CFP, 2102x1736:
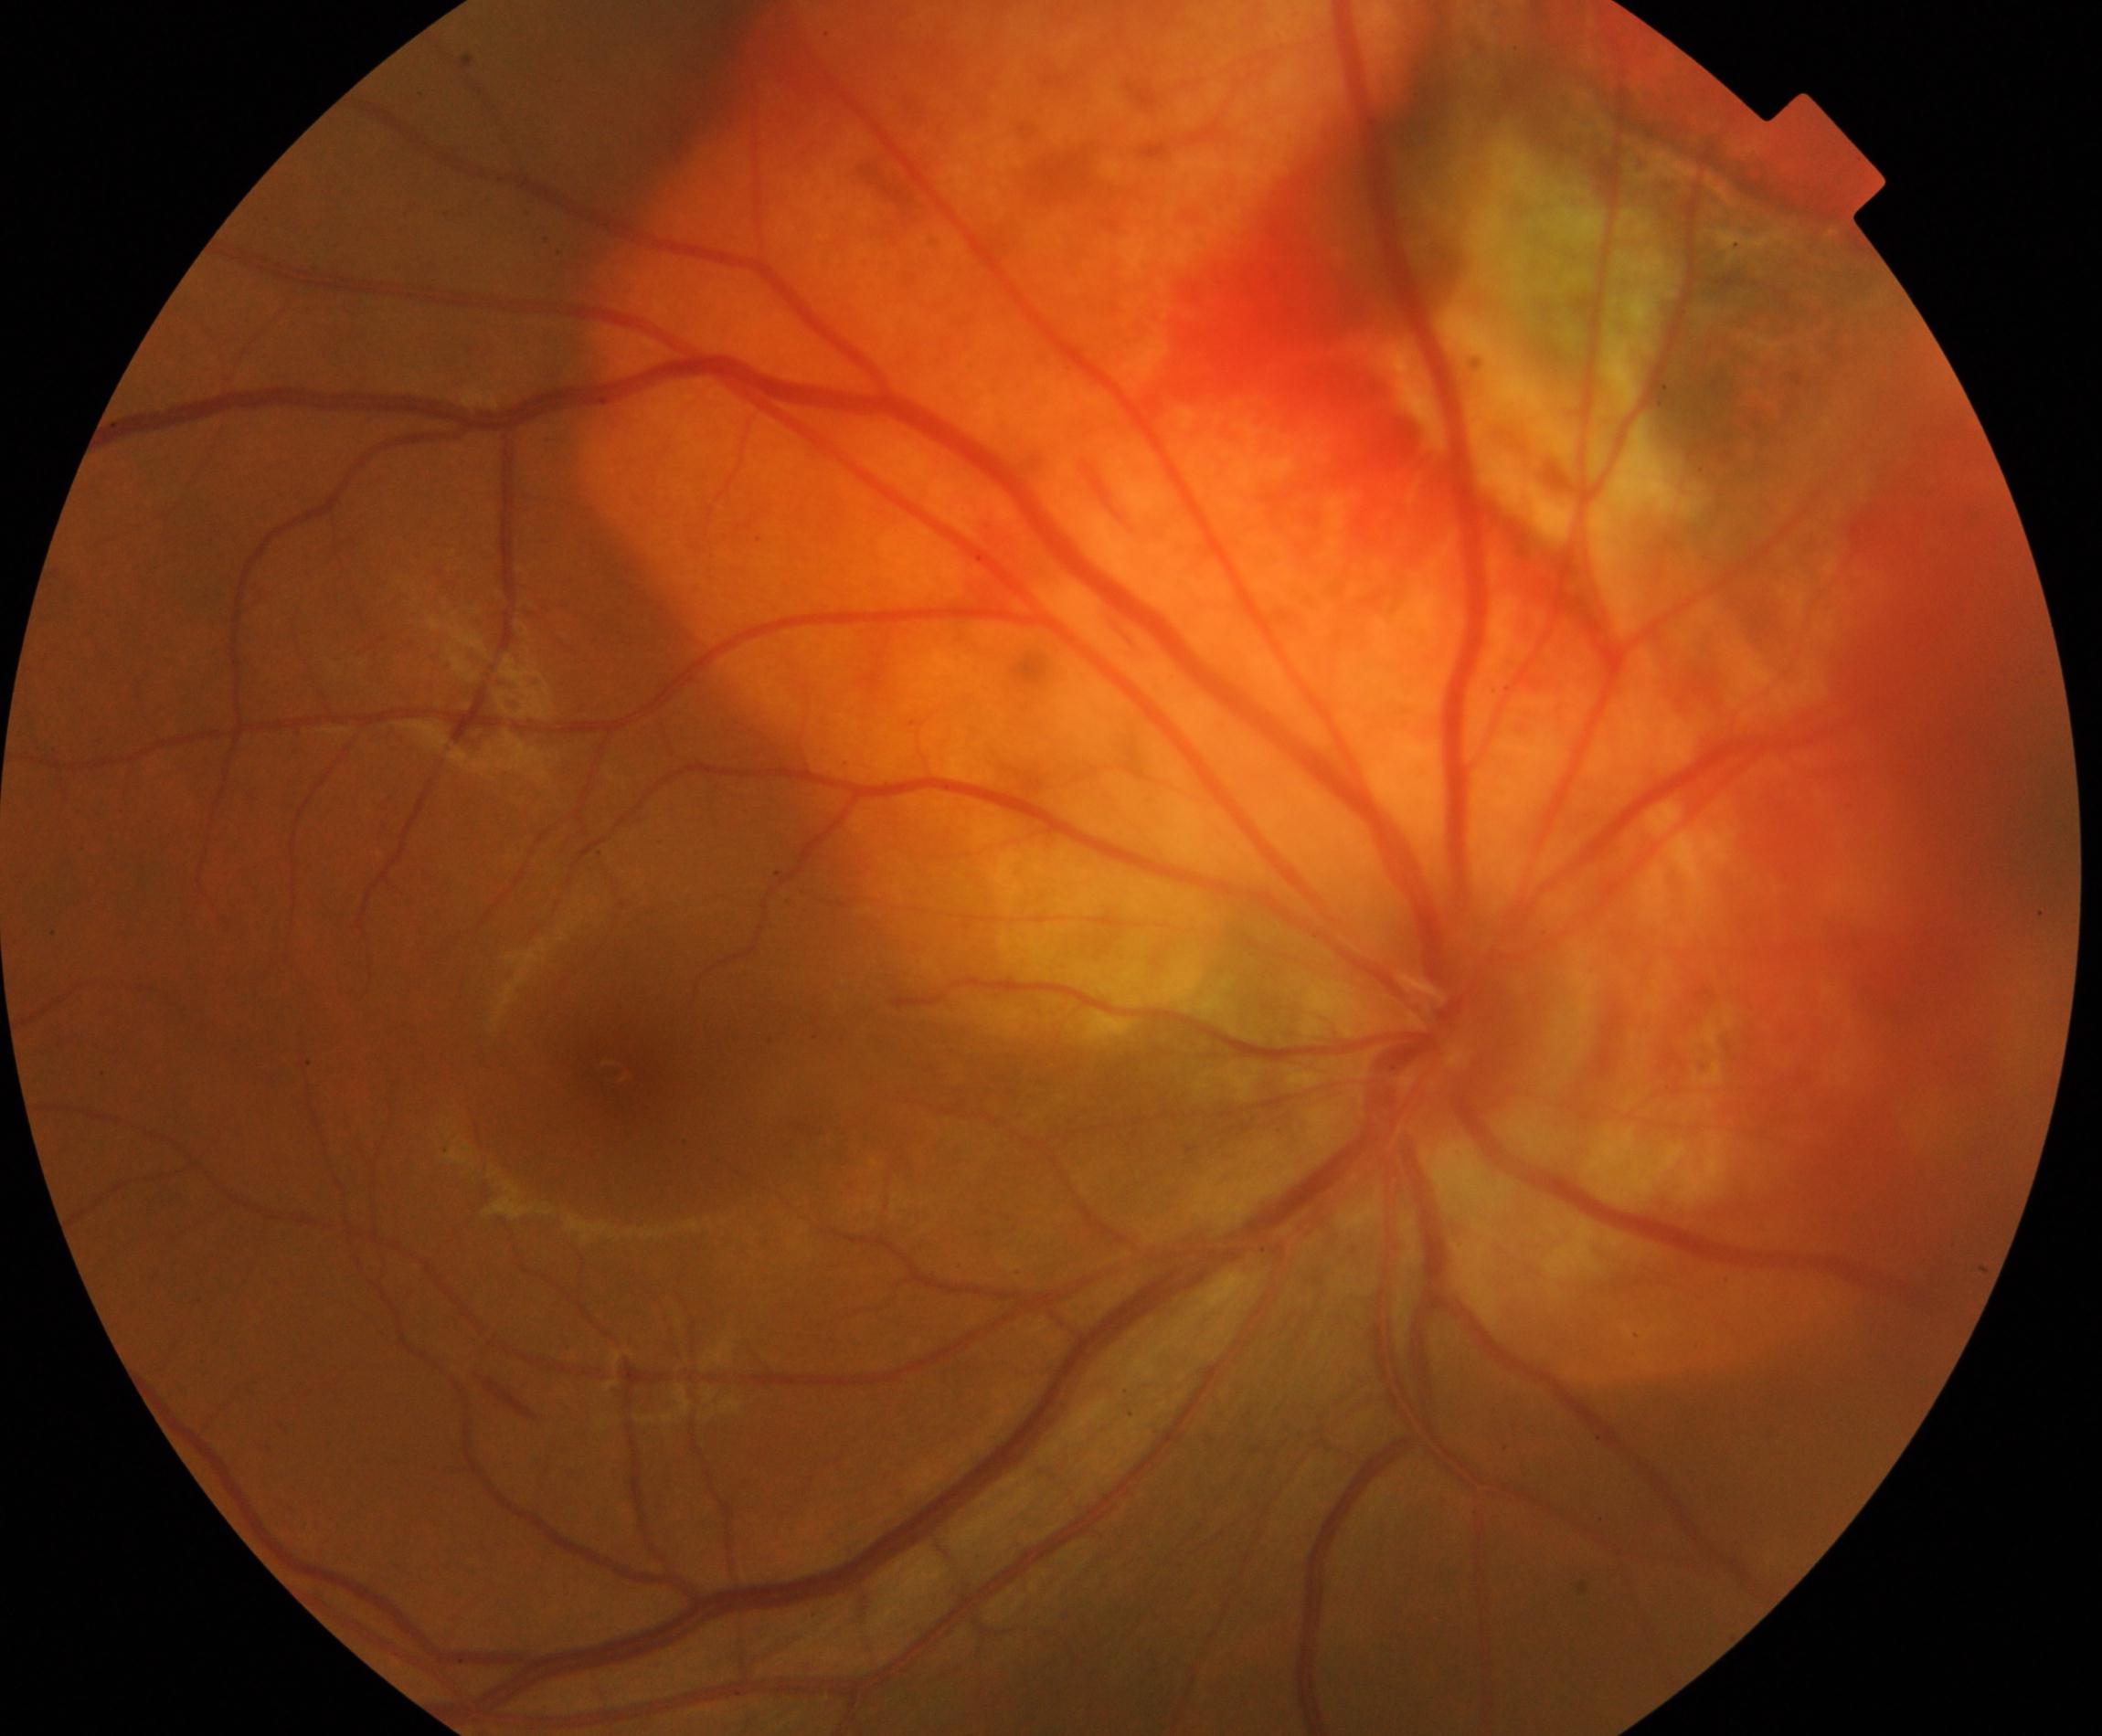
Findings: fundus neoplasm.